RetCam wide-field infant fundus image: 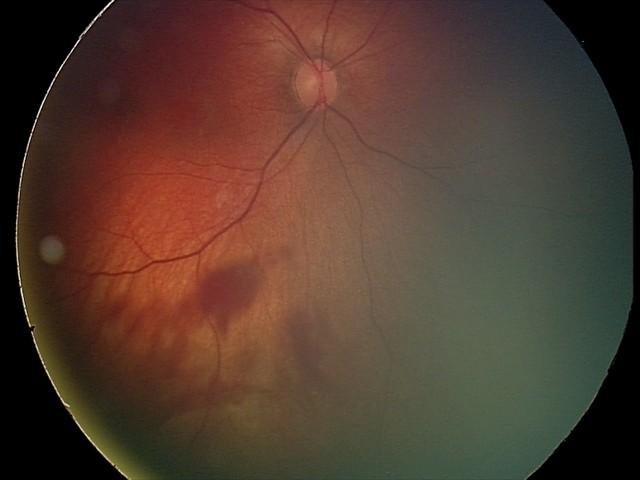
Screening examination consistent with retinal hemorrhages.